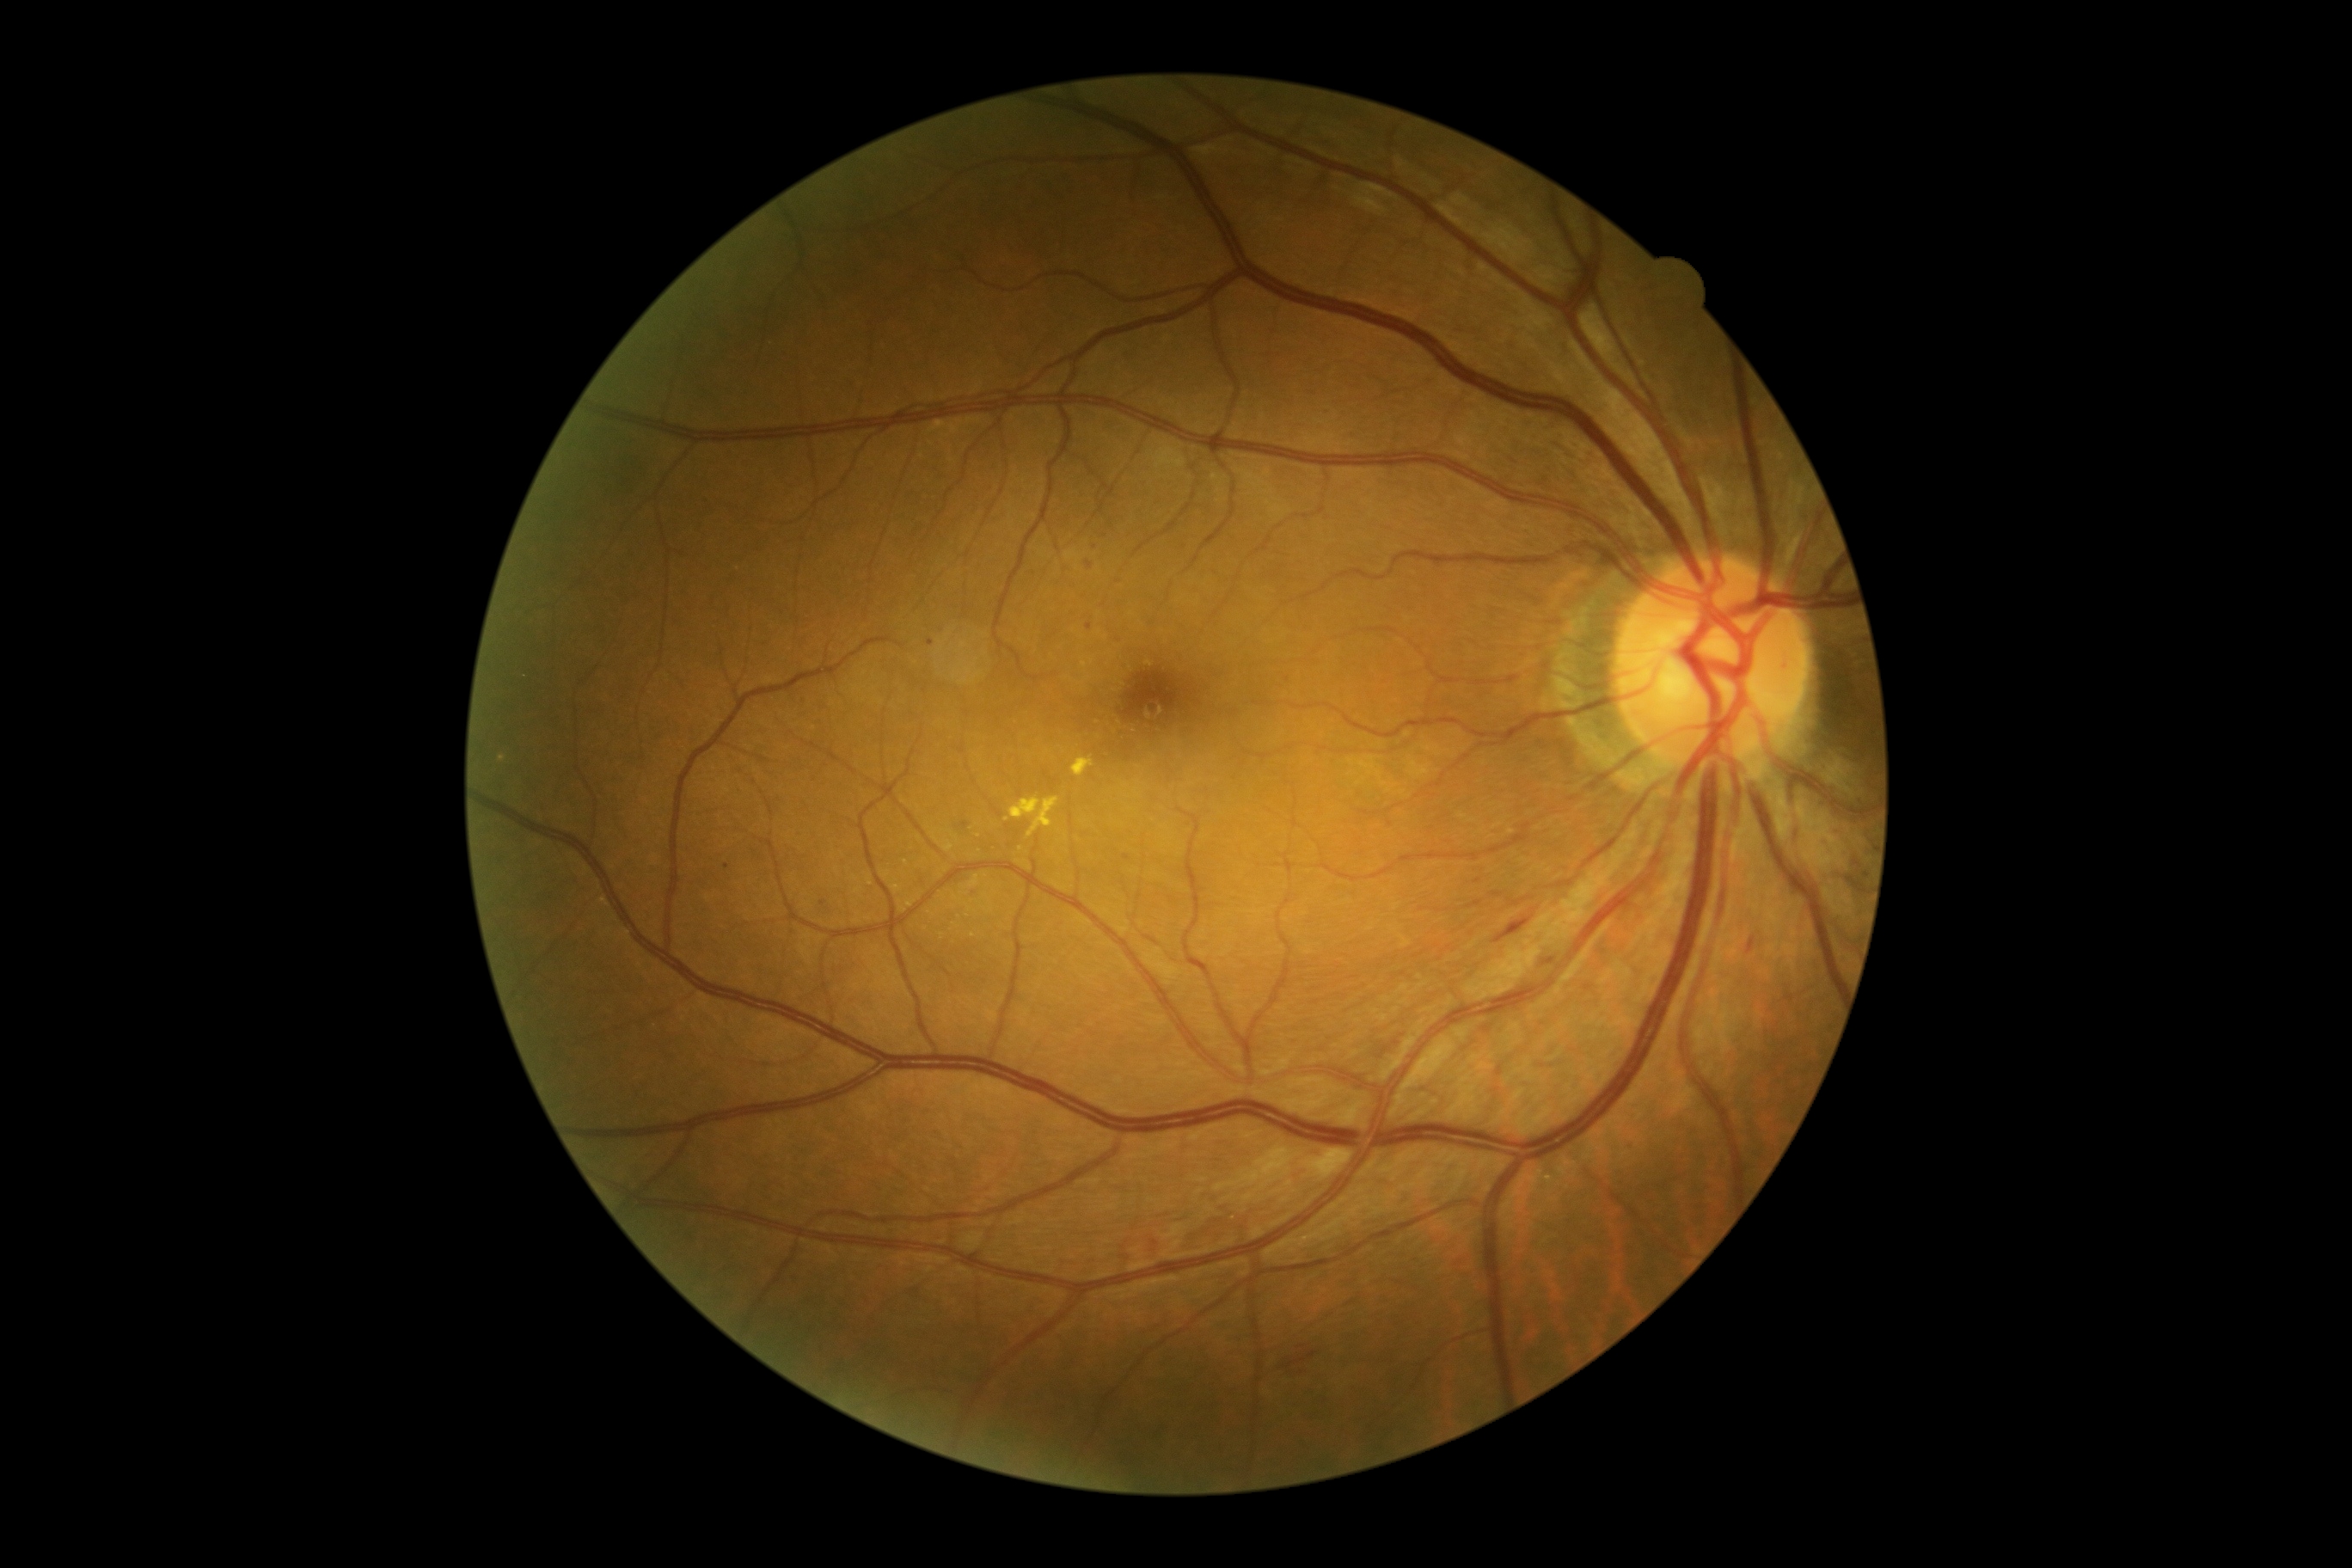
Retinopathy is grade 2 (moderate NPDR).